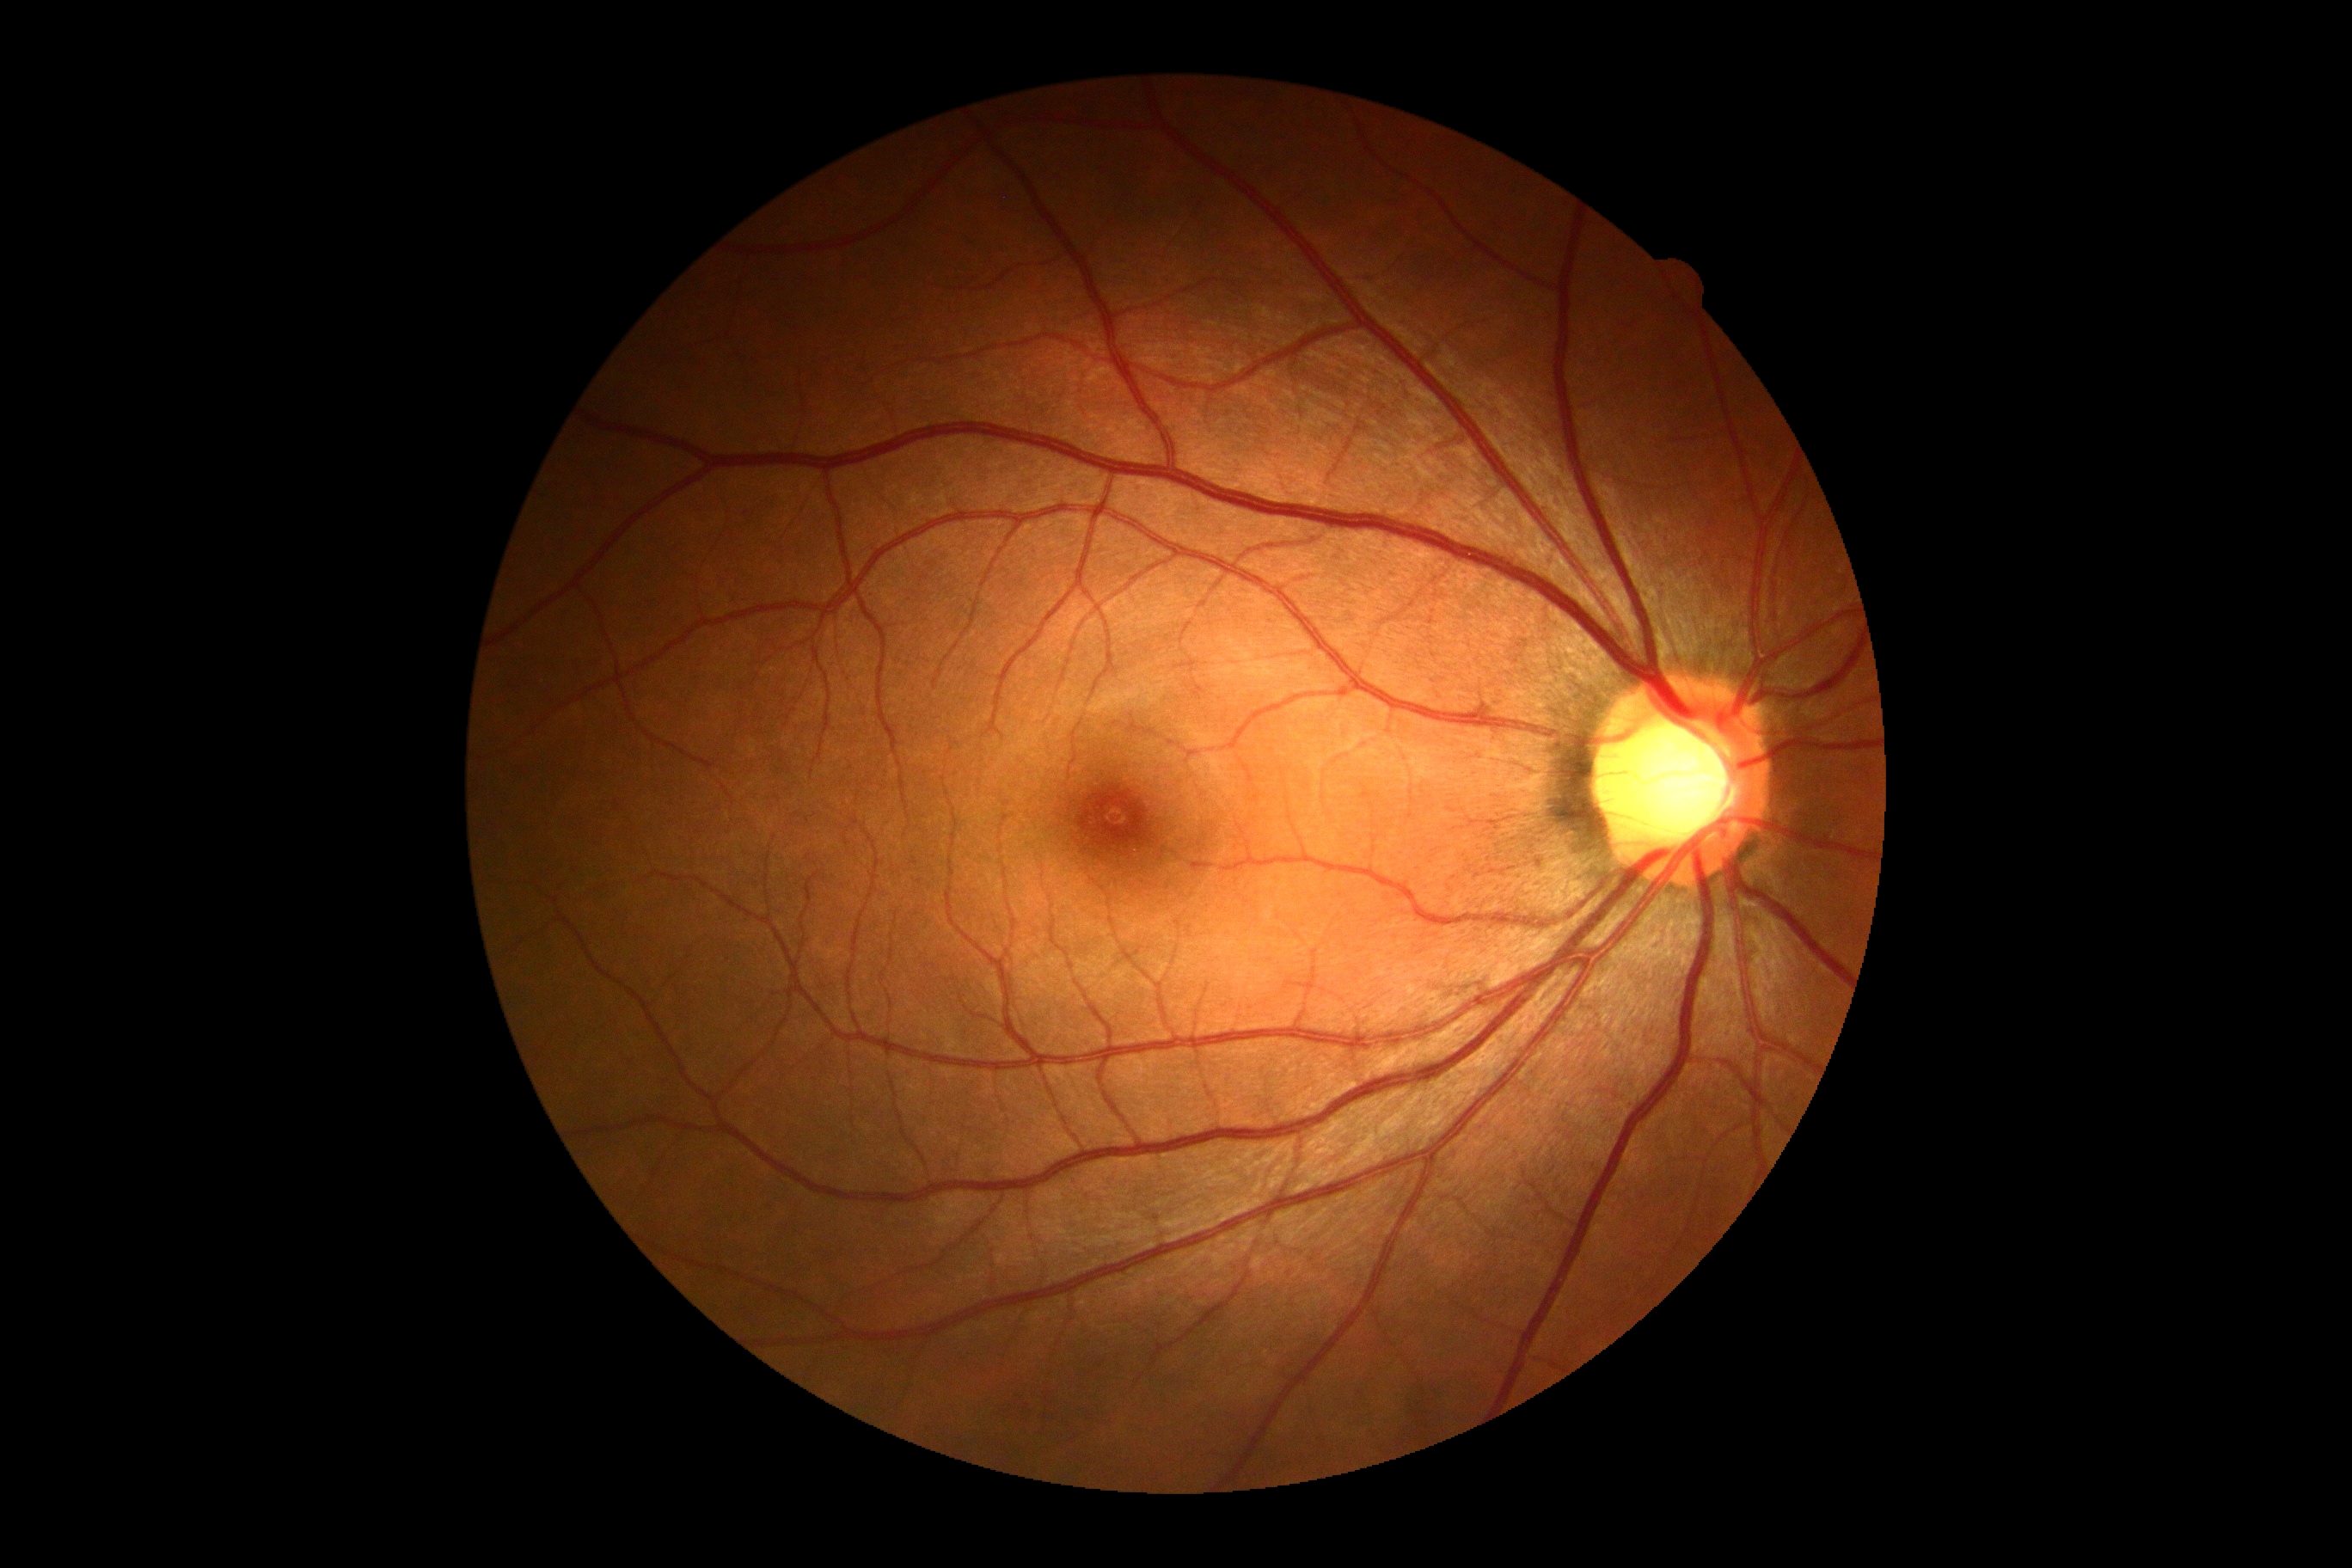 DR grade: 0 (no apparent retinopathy).